Color fundus photograph, 45-degree field of view, modified Davis classification
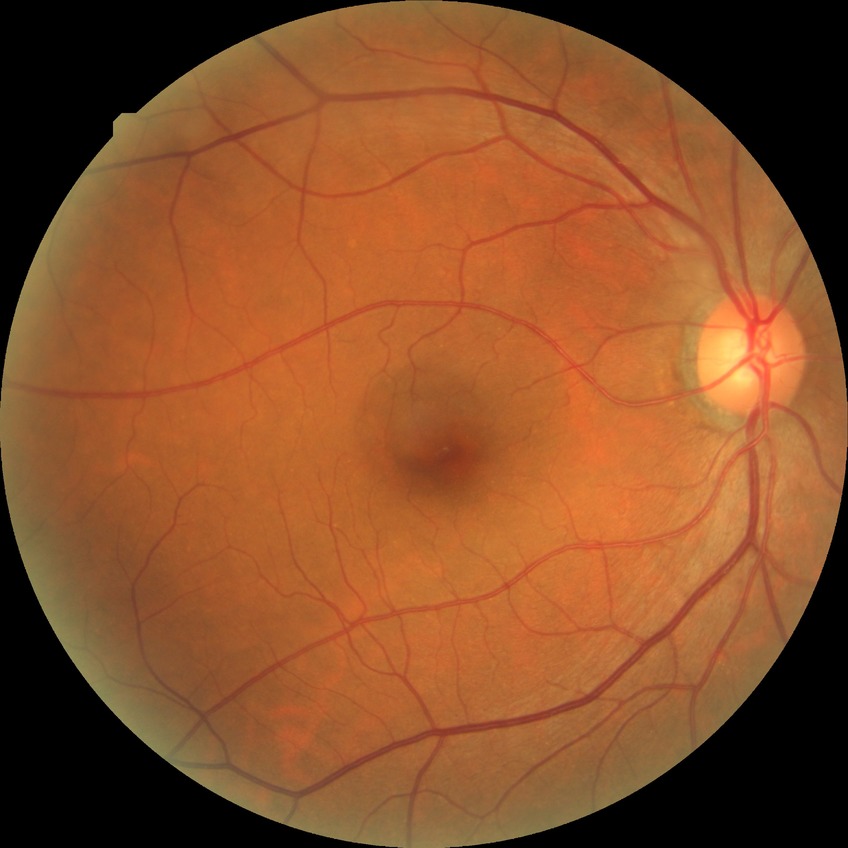

DR = NDR.